Modified Davis grading; 45° field of view; image size 848x848: 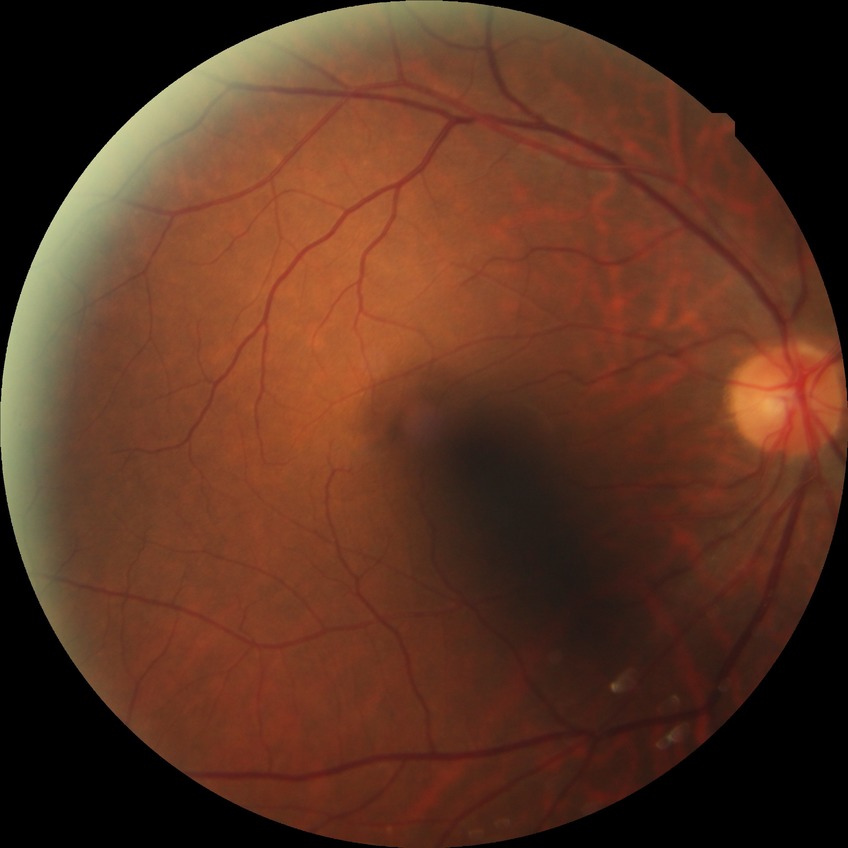

retinopathy stage: no diabetic retinopathy.